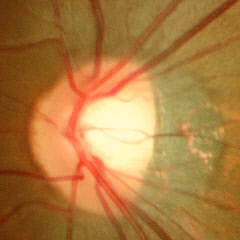

Assessment: no glaucoma.